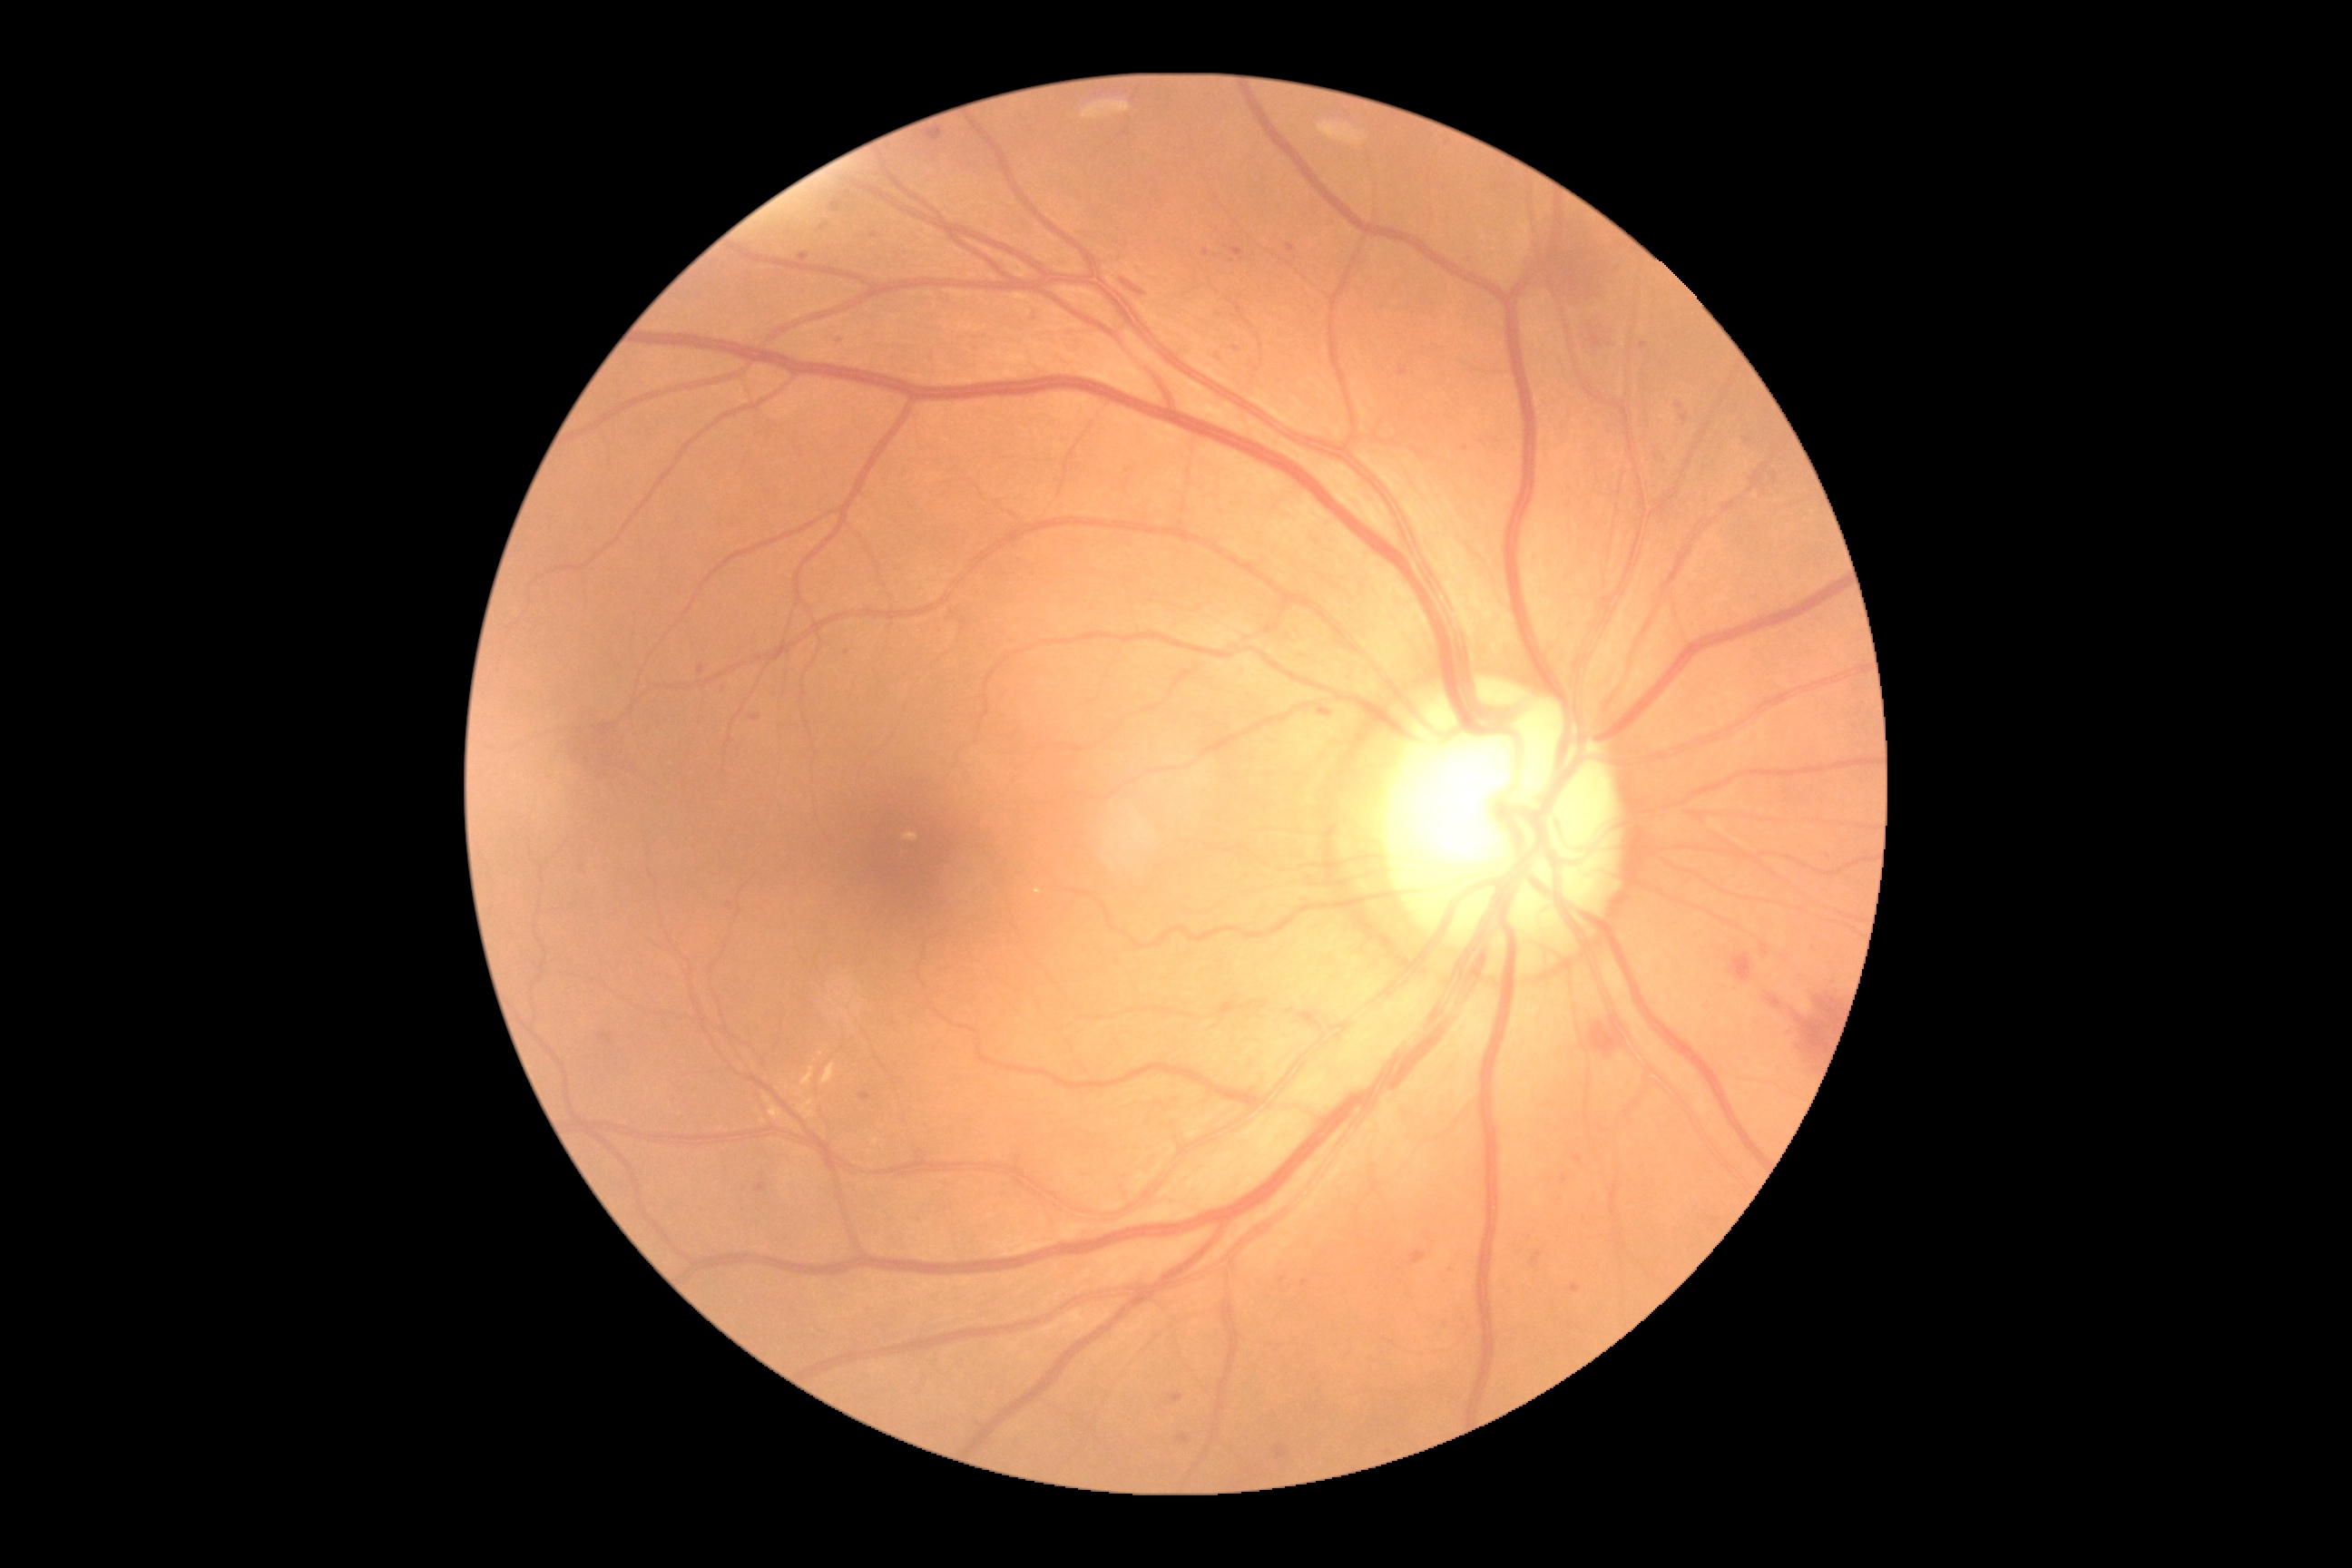

The retinopathy is classified as non-proliferative diabetic retinopathy. DR: 2.